Posterior pole color fundus photograph.
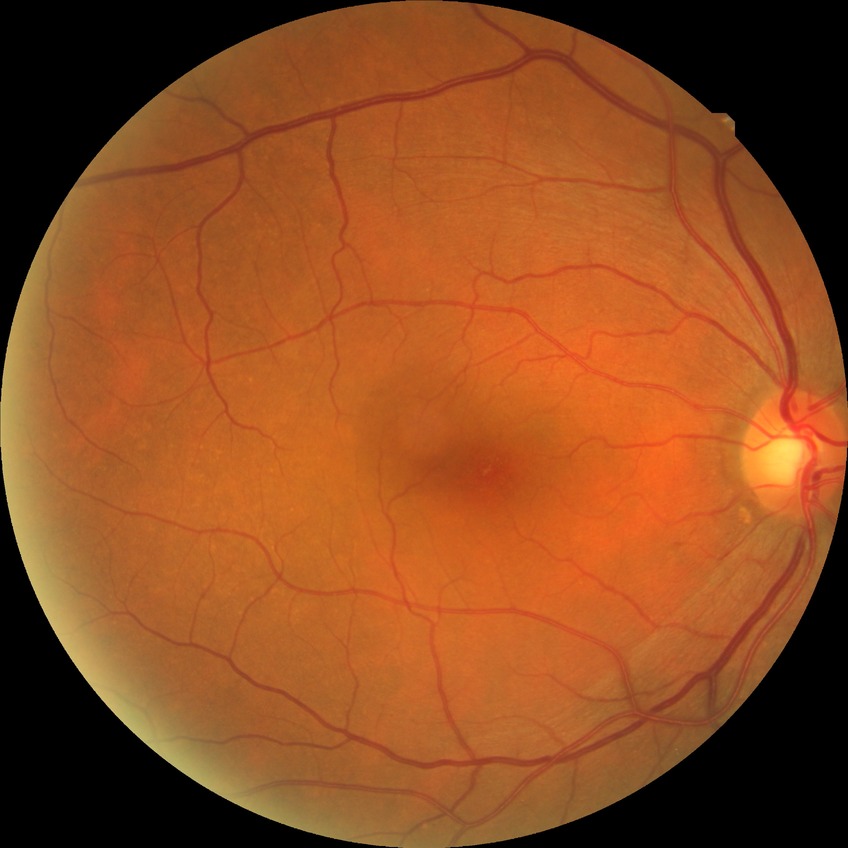

Diabetic retinopathy stage is no diabetic retinopathy.